45° field of view · retinal fundus photograph · 2352 x 1568 pixels — 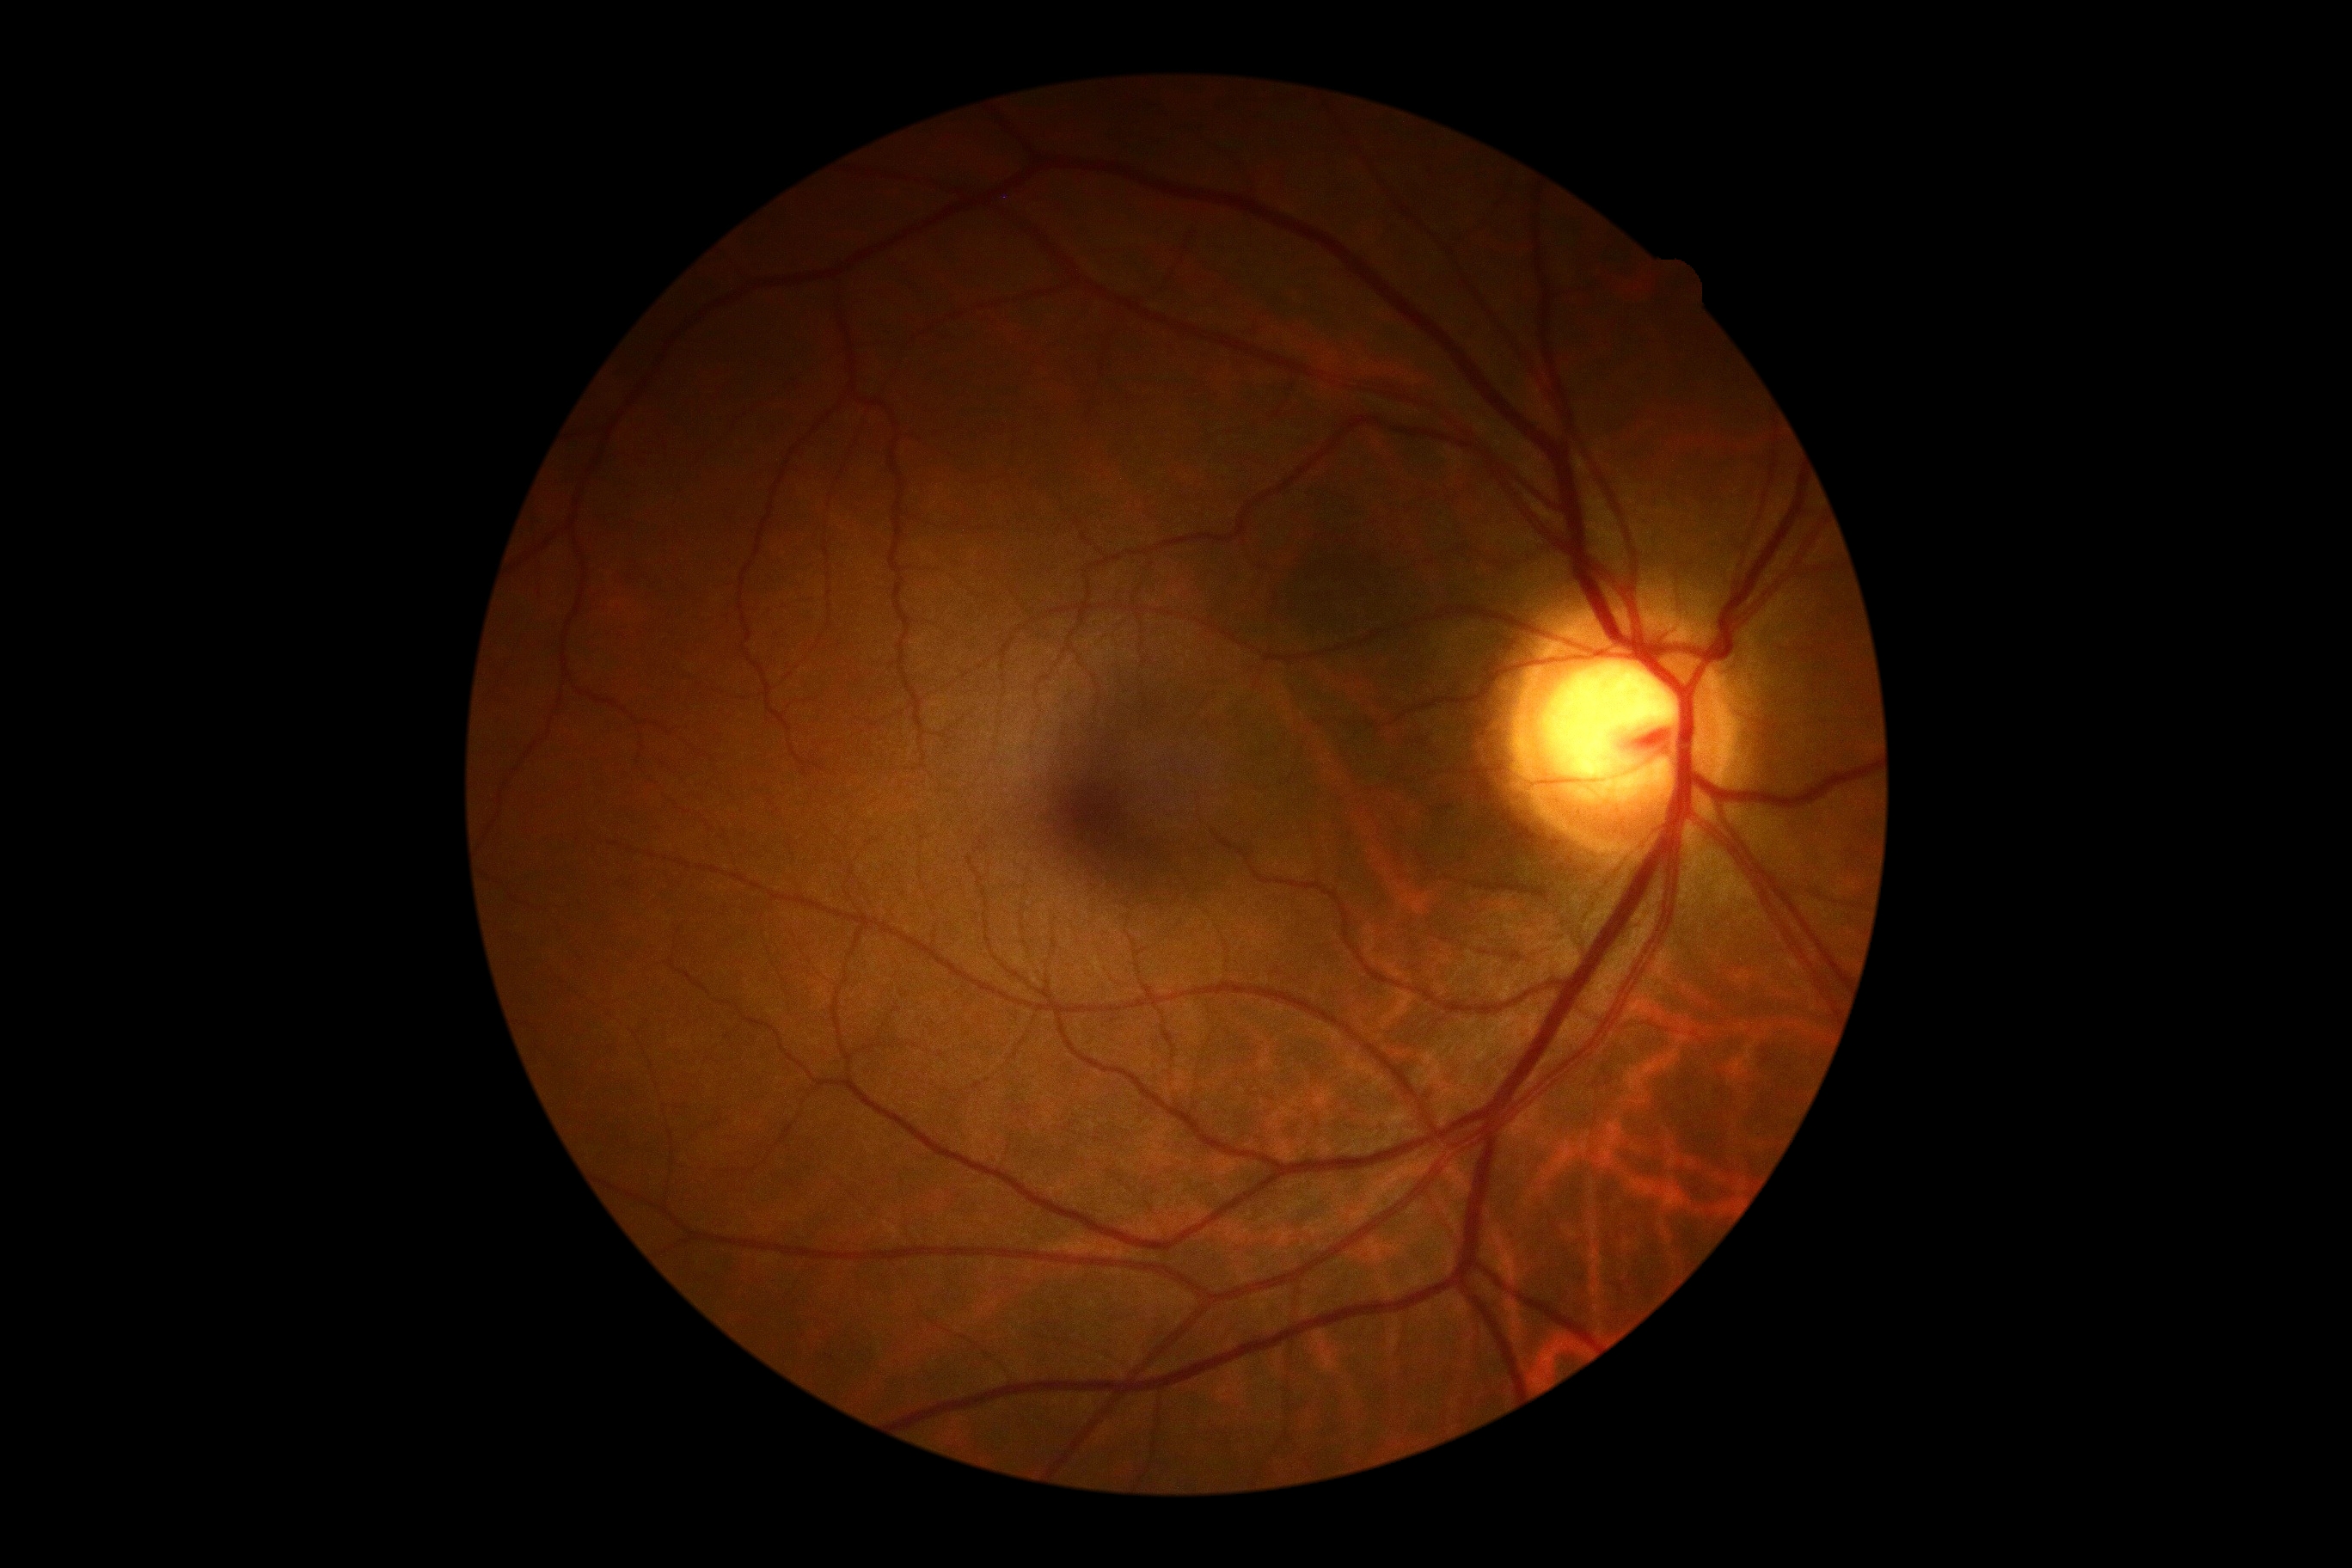
diabetic retinopathy (DR) = grade 0 — no visible signs of diabetic retinopathy.